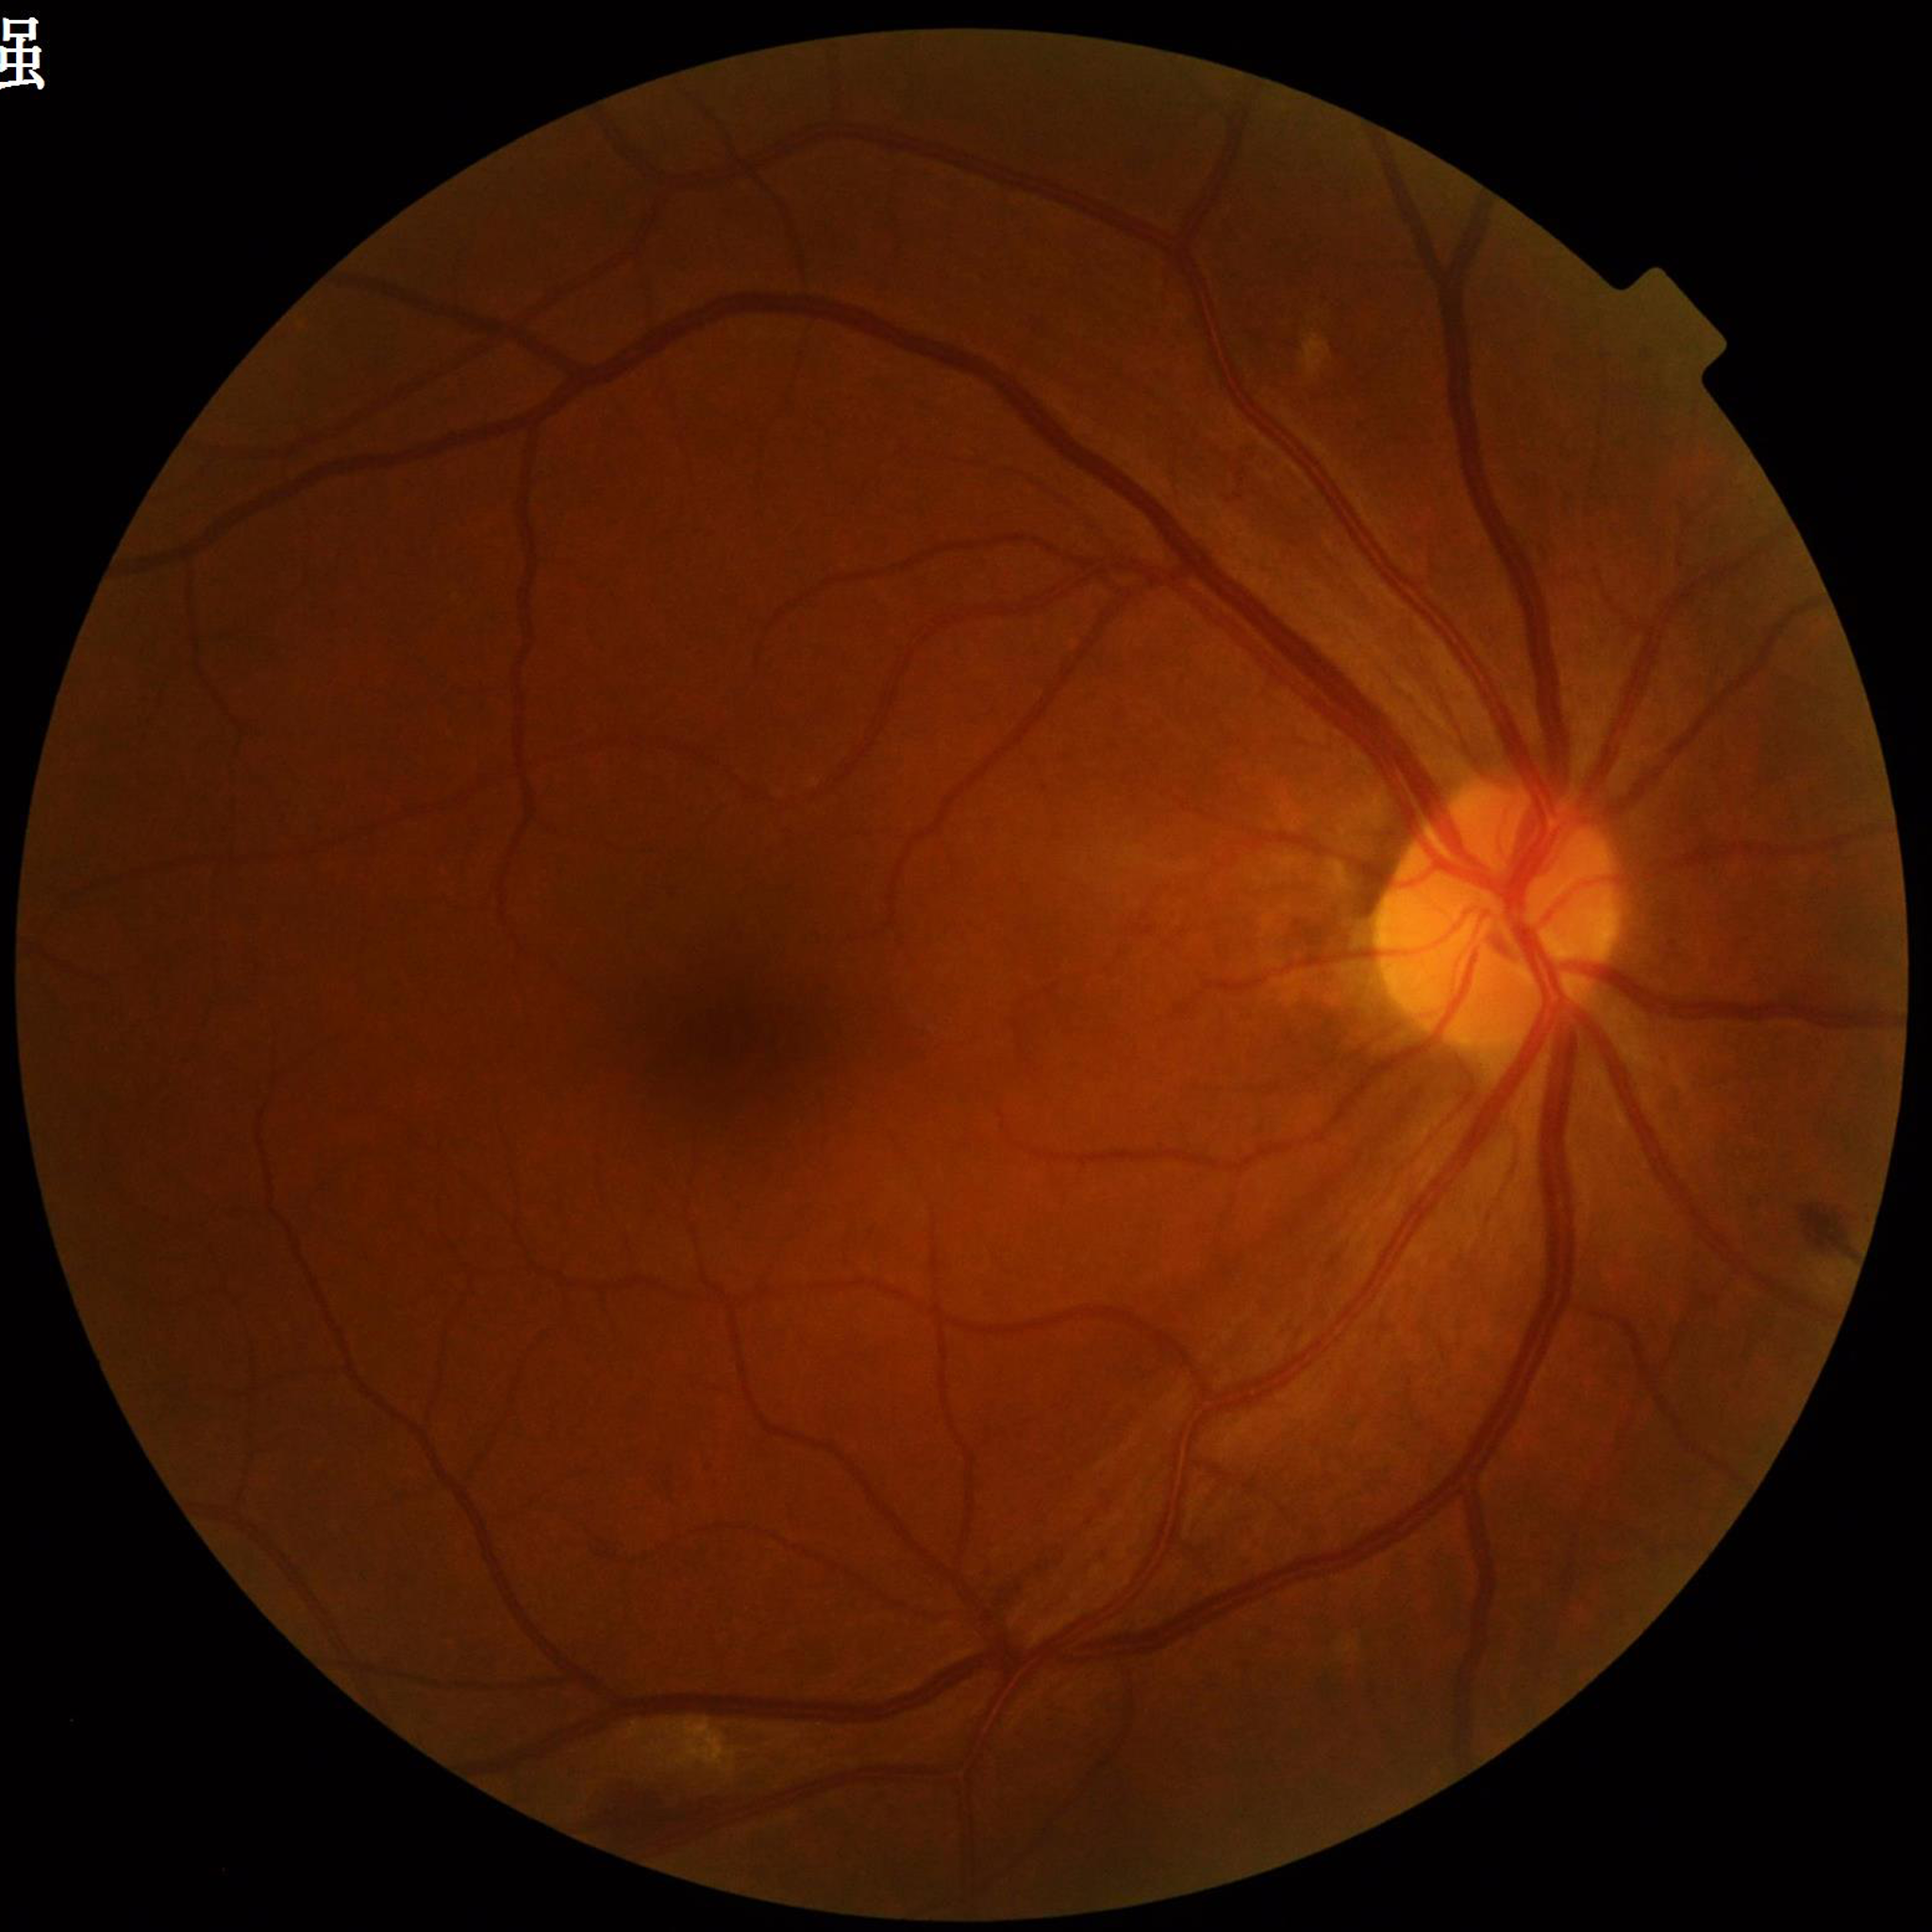
Retinal fundus photograph from a patient with DR.